Retinal fundus photograph; 45-degree field of view: 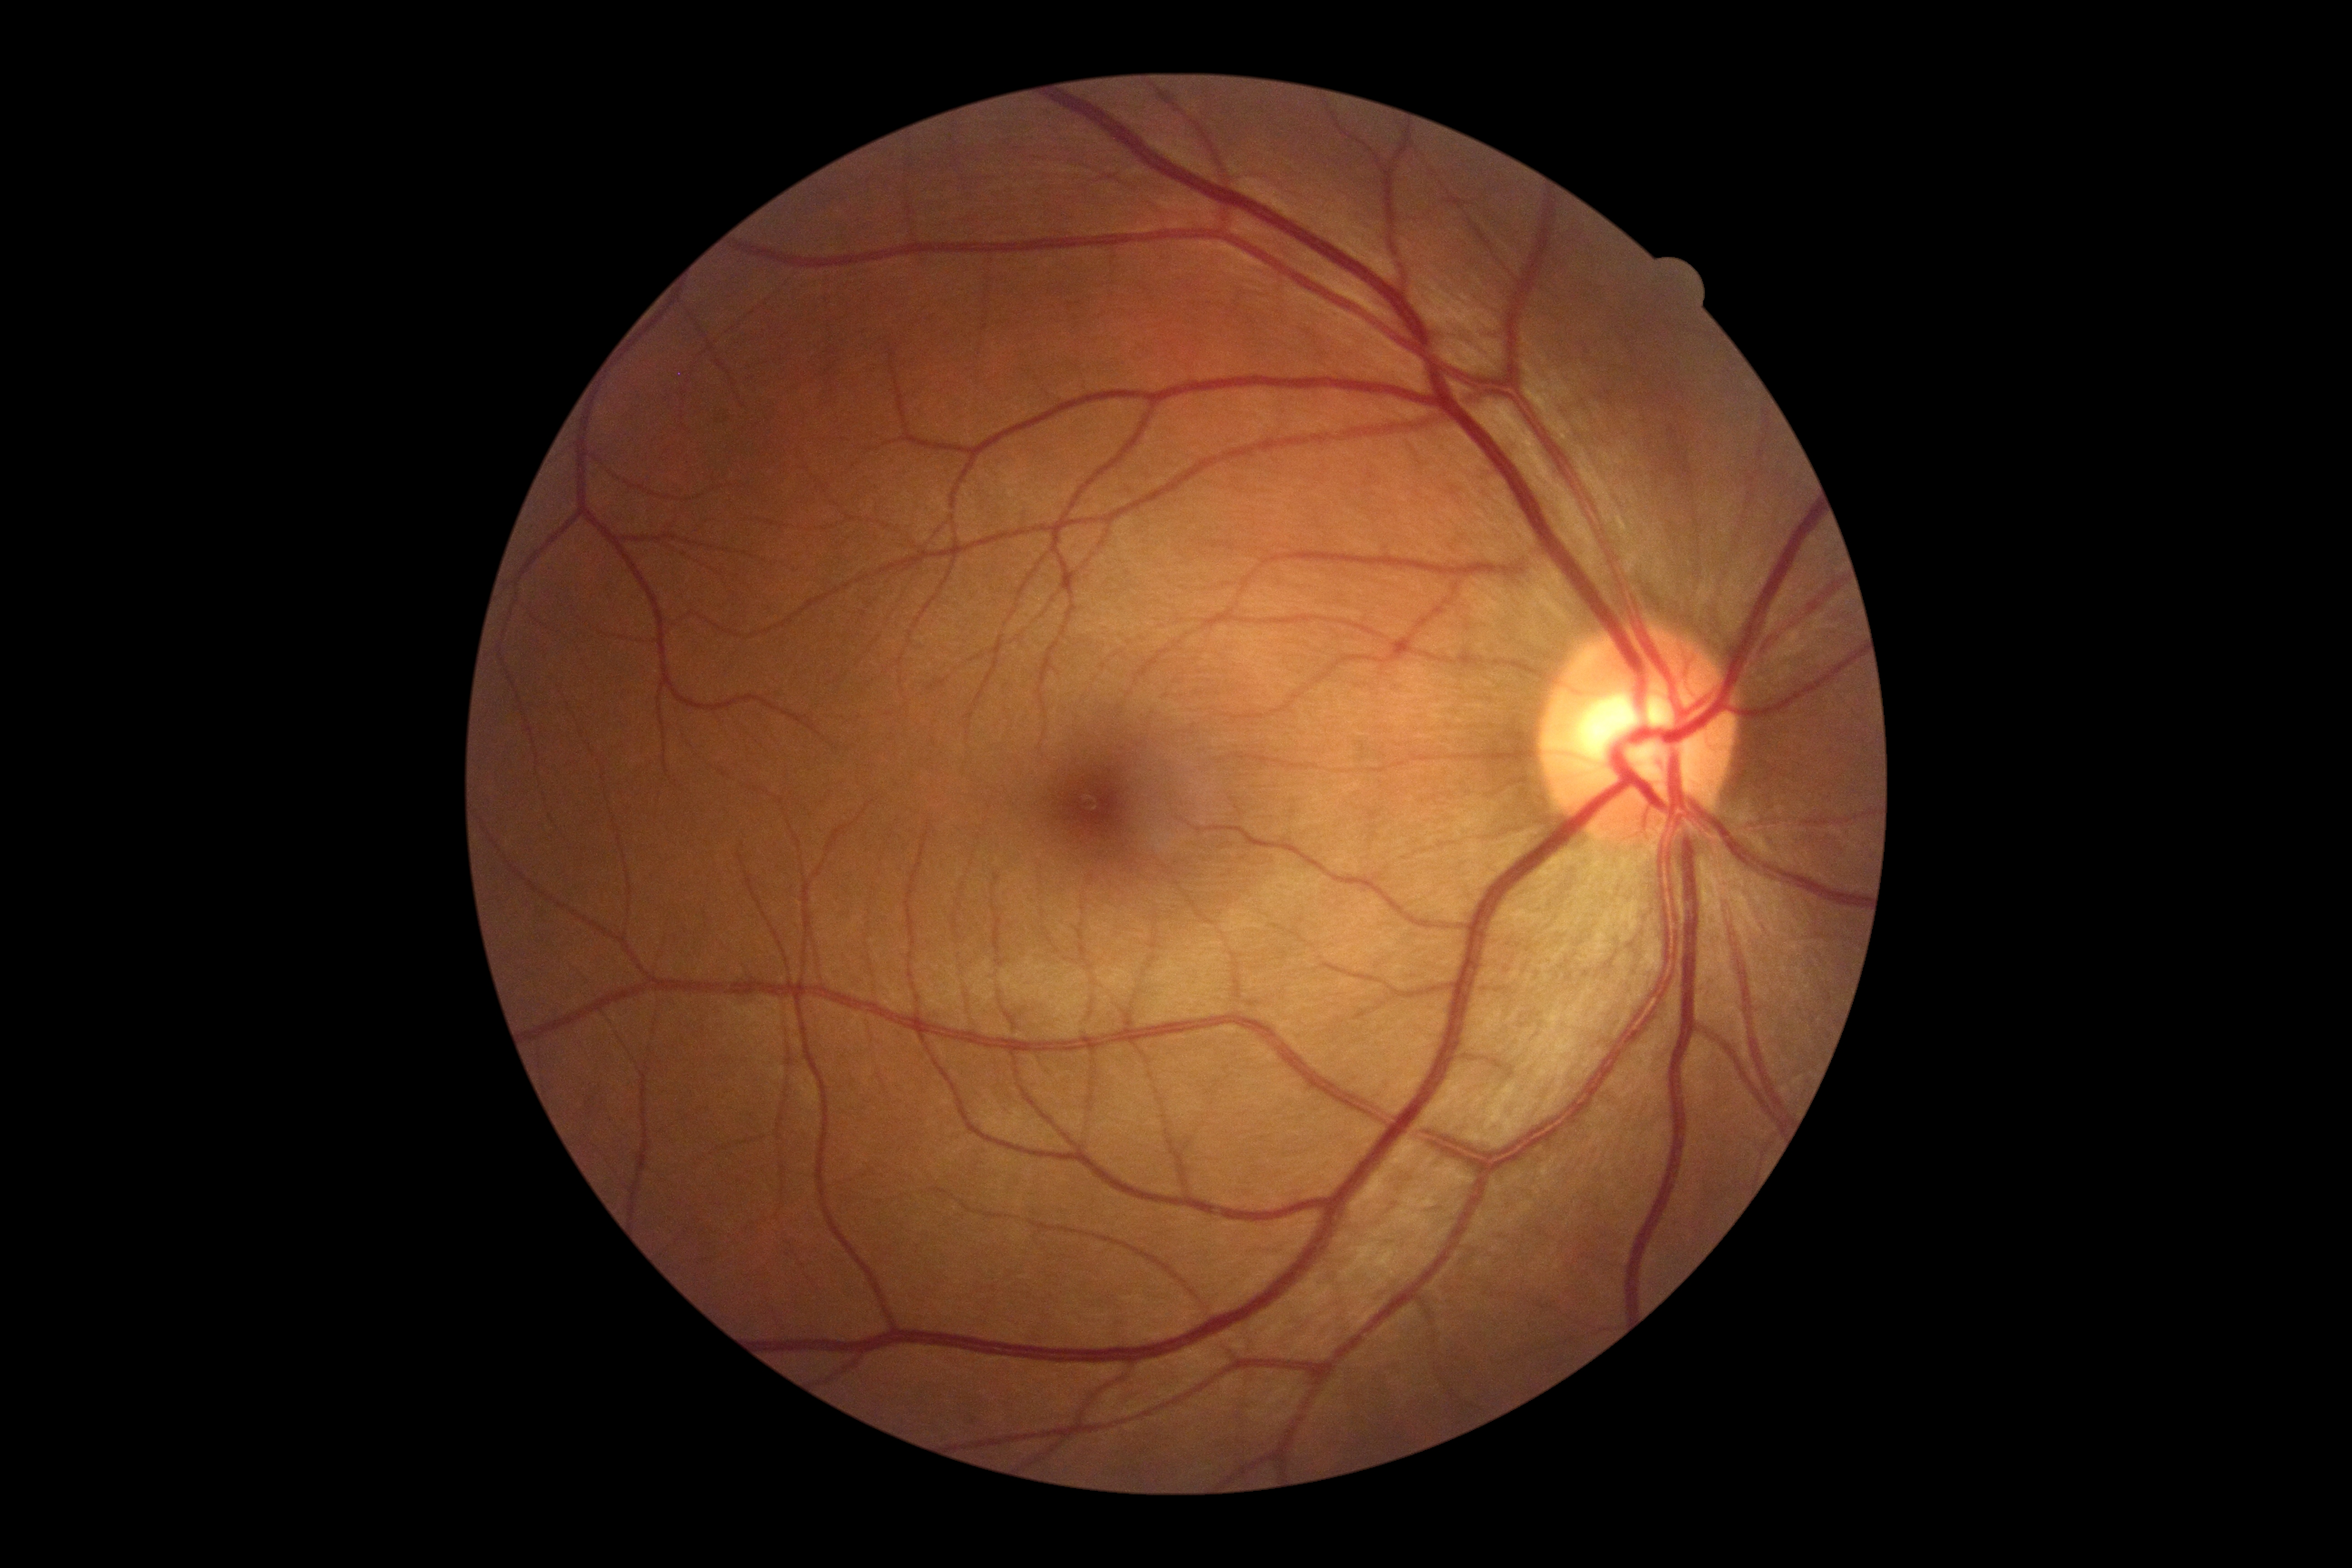

Annotations:
– diabetic retinopathy grade — no apparent retinopathy (0)